Color fundus photograph. 2212x1659px. FOV: 45 degrees:
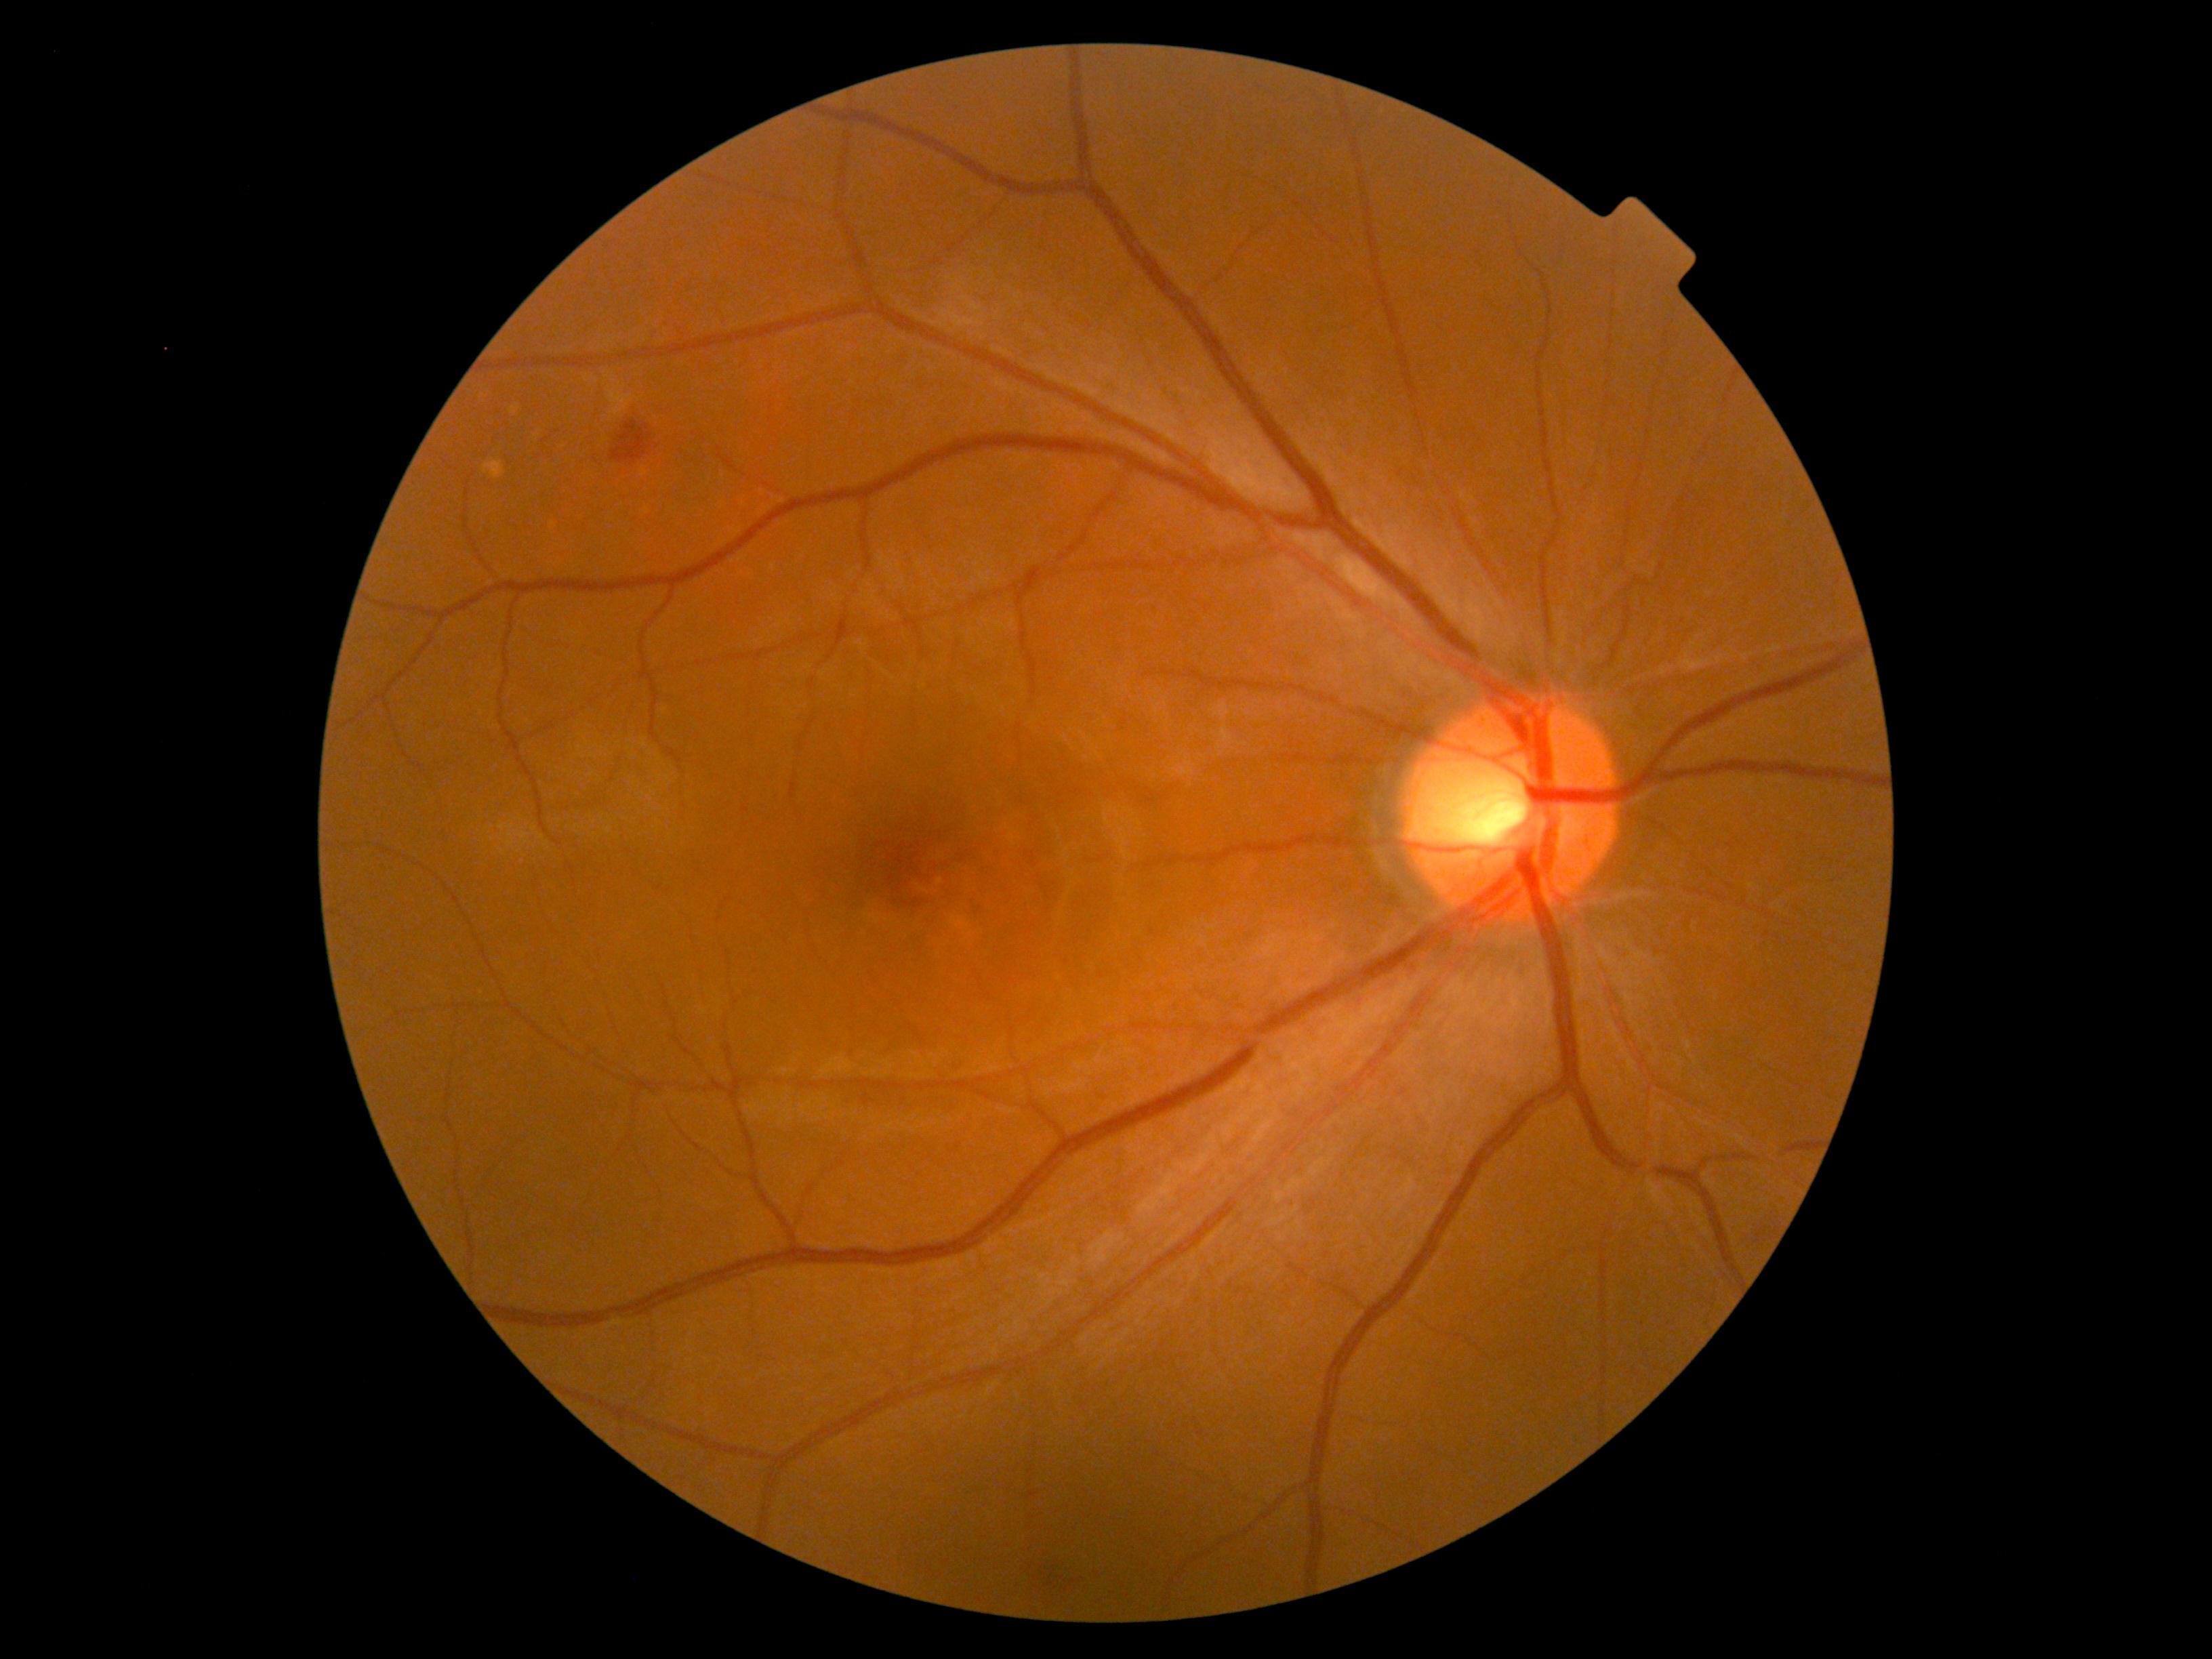 DR is grade 2.